Graded on the modified Davis scale, nonmydriatic.
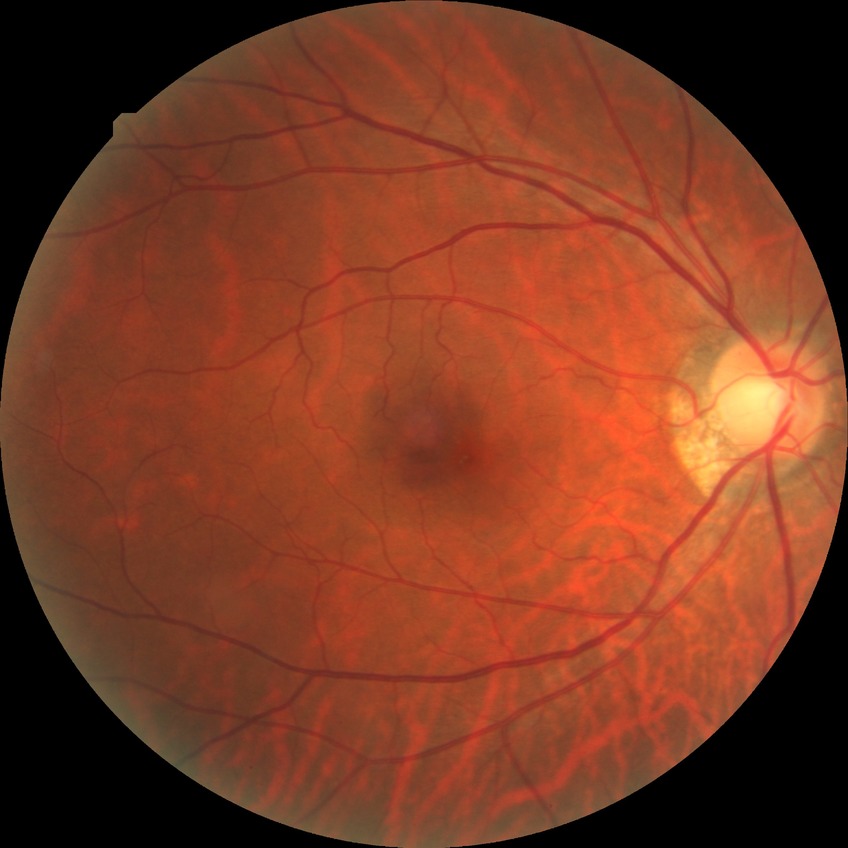

retinopathy stage = no diabetic retinopathy.